Image size 848x848, acquired with a NIDEK AFC-230, 45 degree fundus photograph — 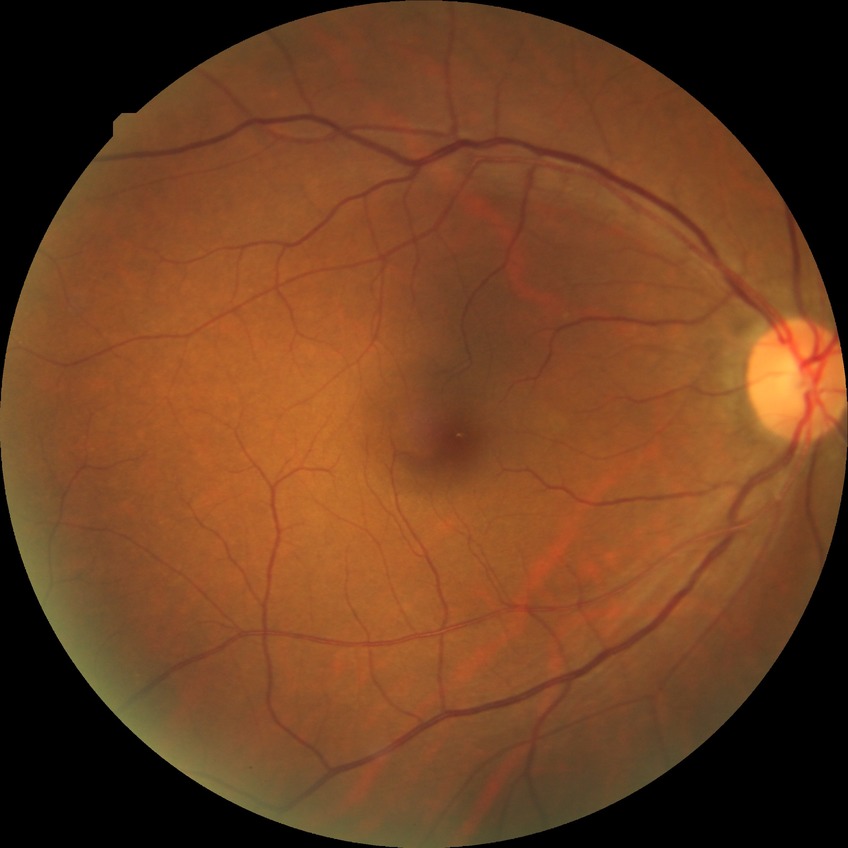
Davis DR grade: NDR.